Wide-field fundus image from infant ROP screening. Natus RetCam Envision, 130° FOV:
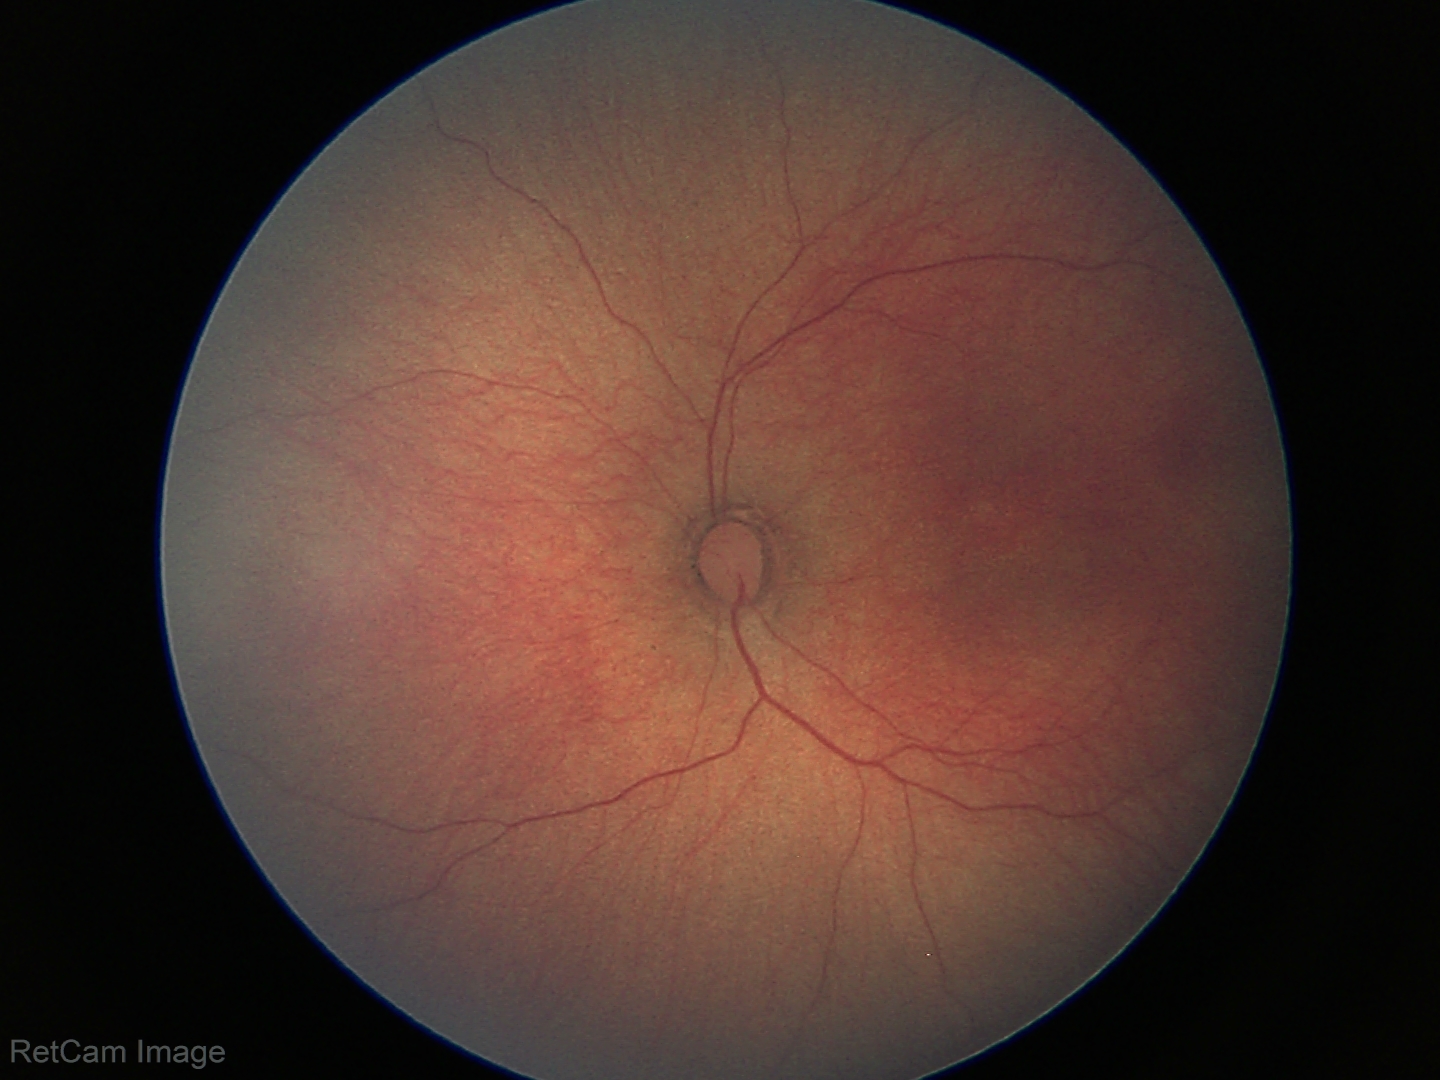

Normal screening examination.